Retinal fundus photograph; 240x240.
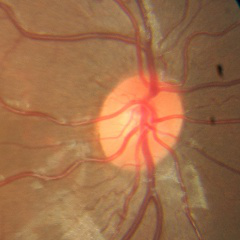
There is evidence of no glaucoma.